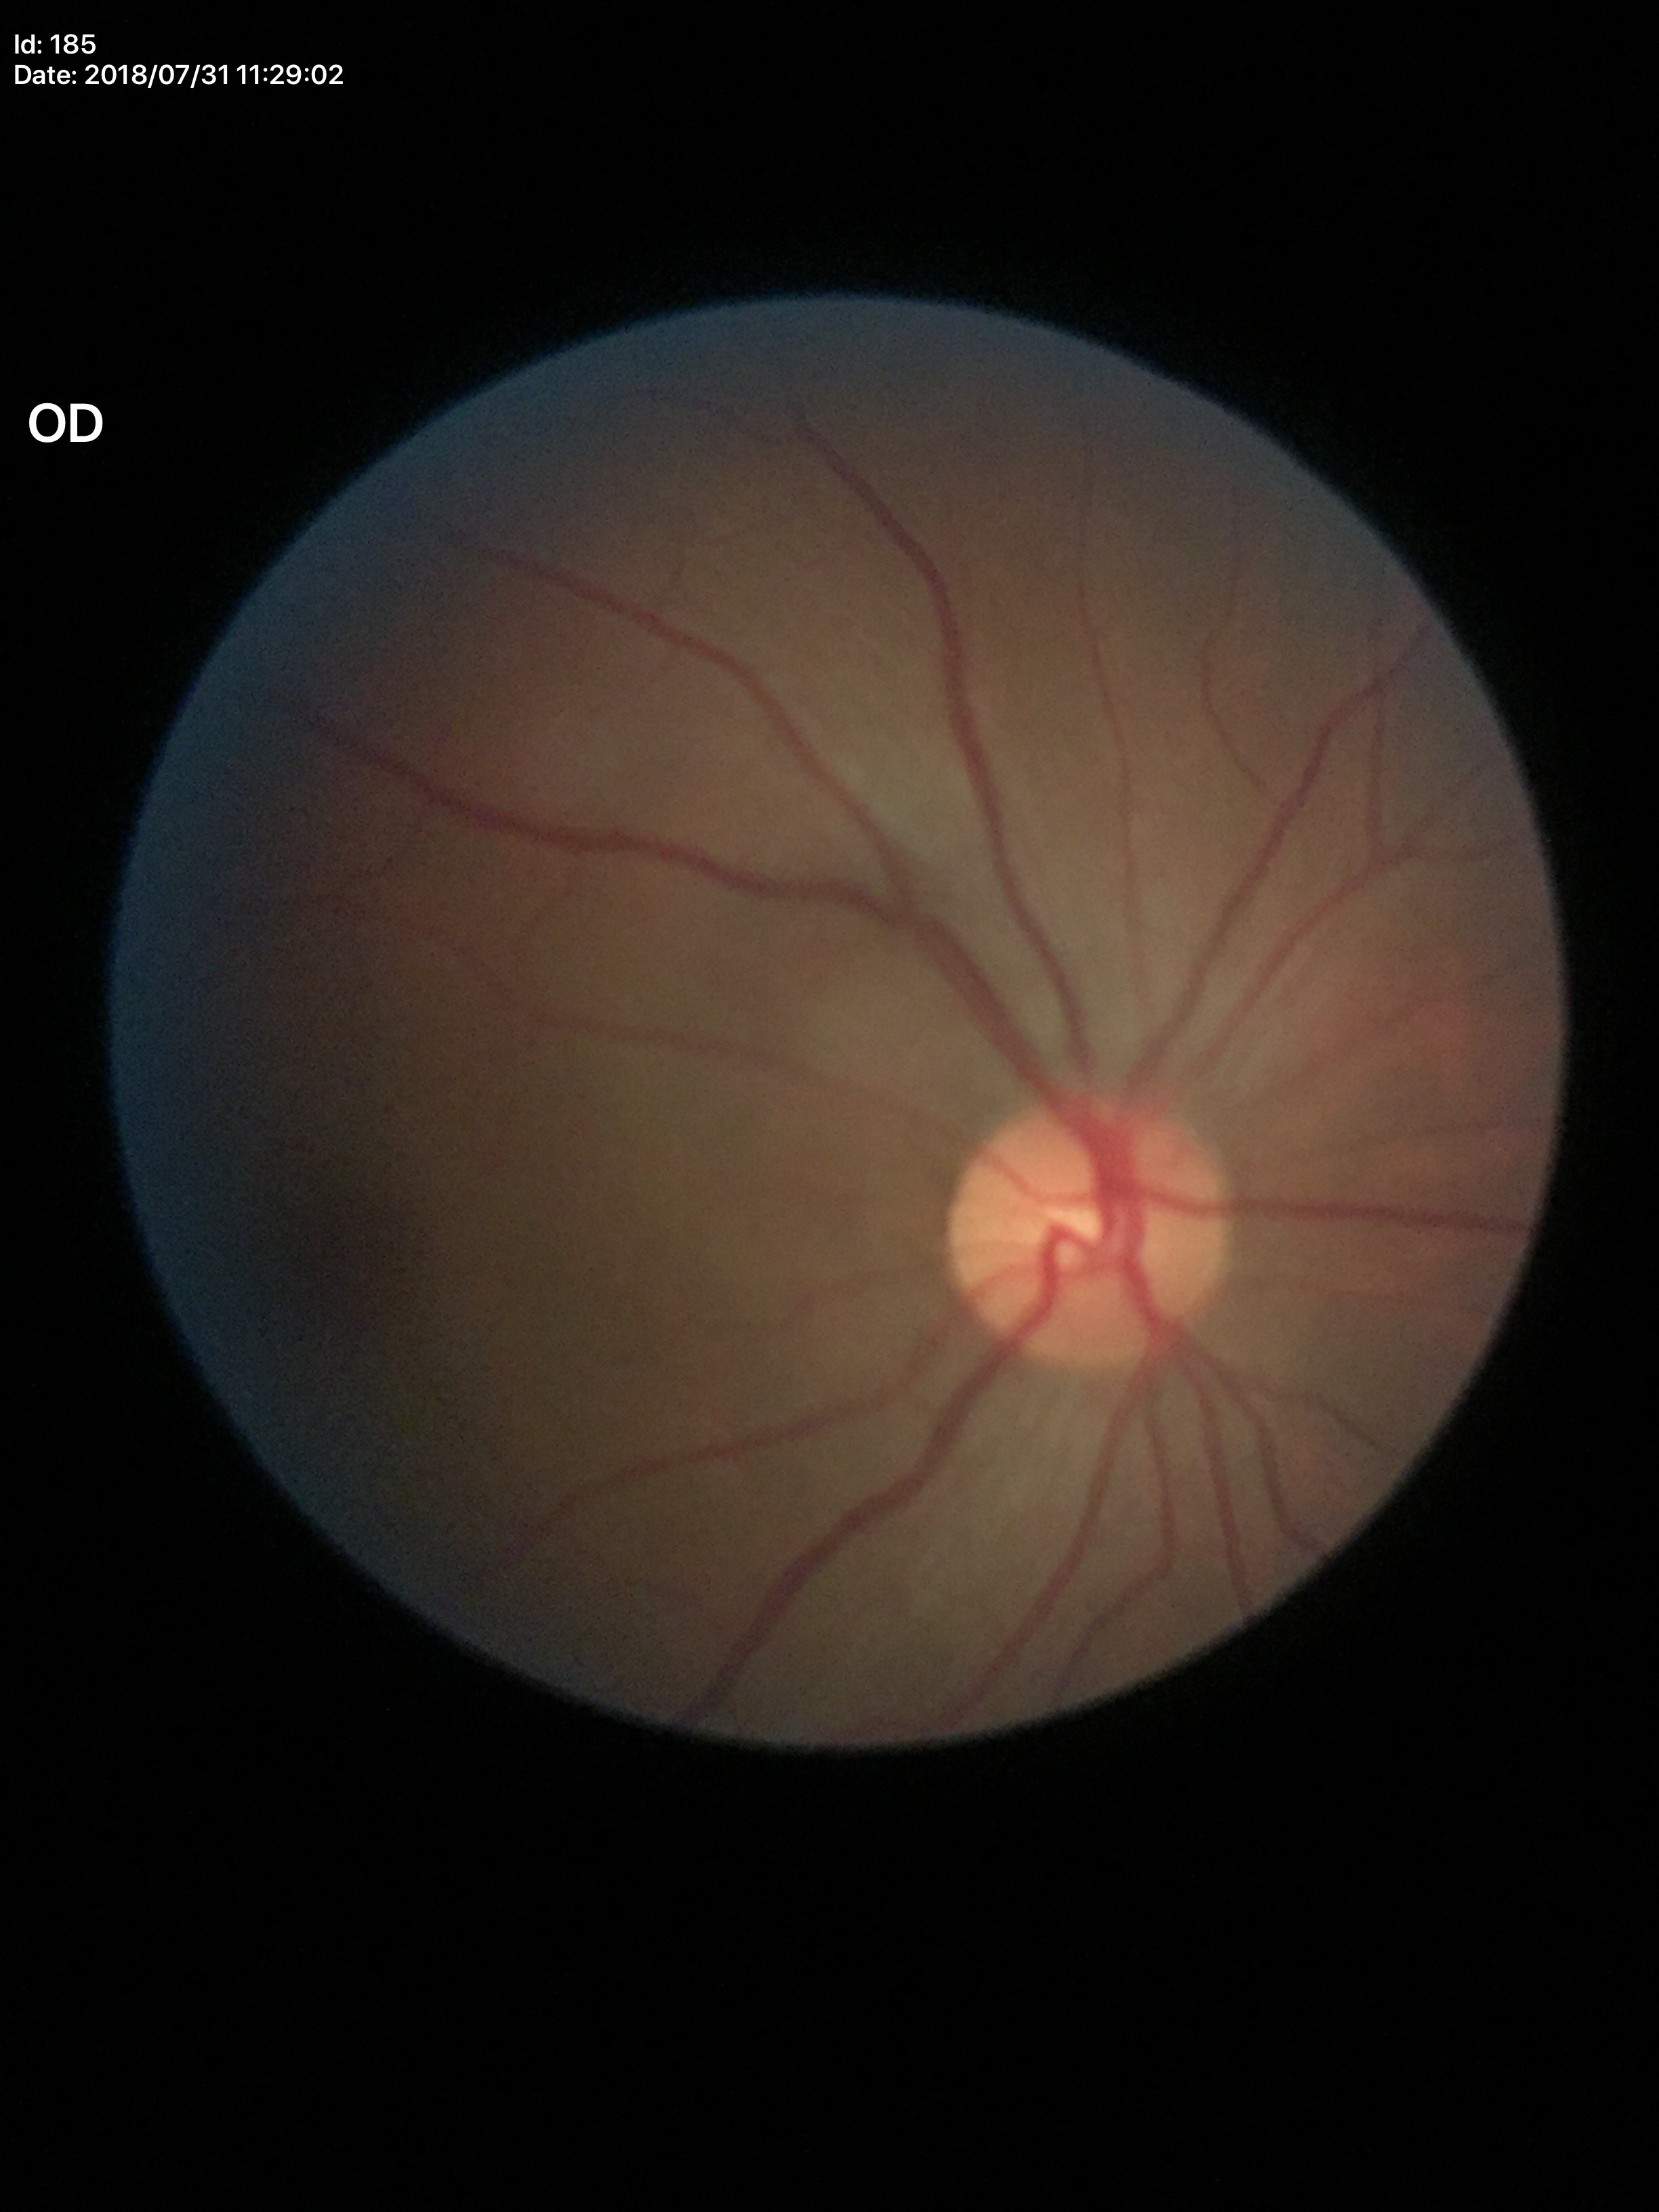

No glaucomatous findings. Vertical CDR: 0.38.